FOV: 45 degrees: 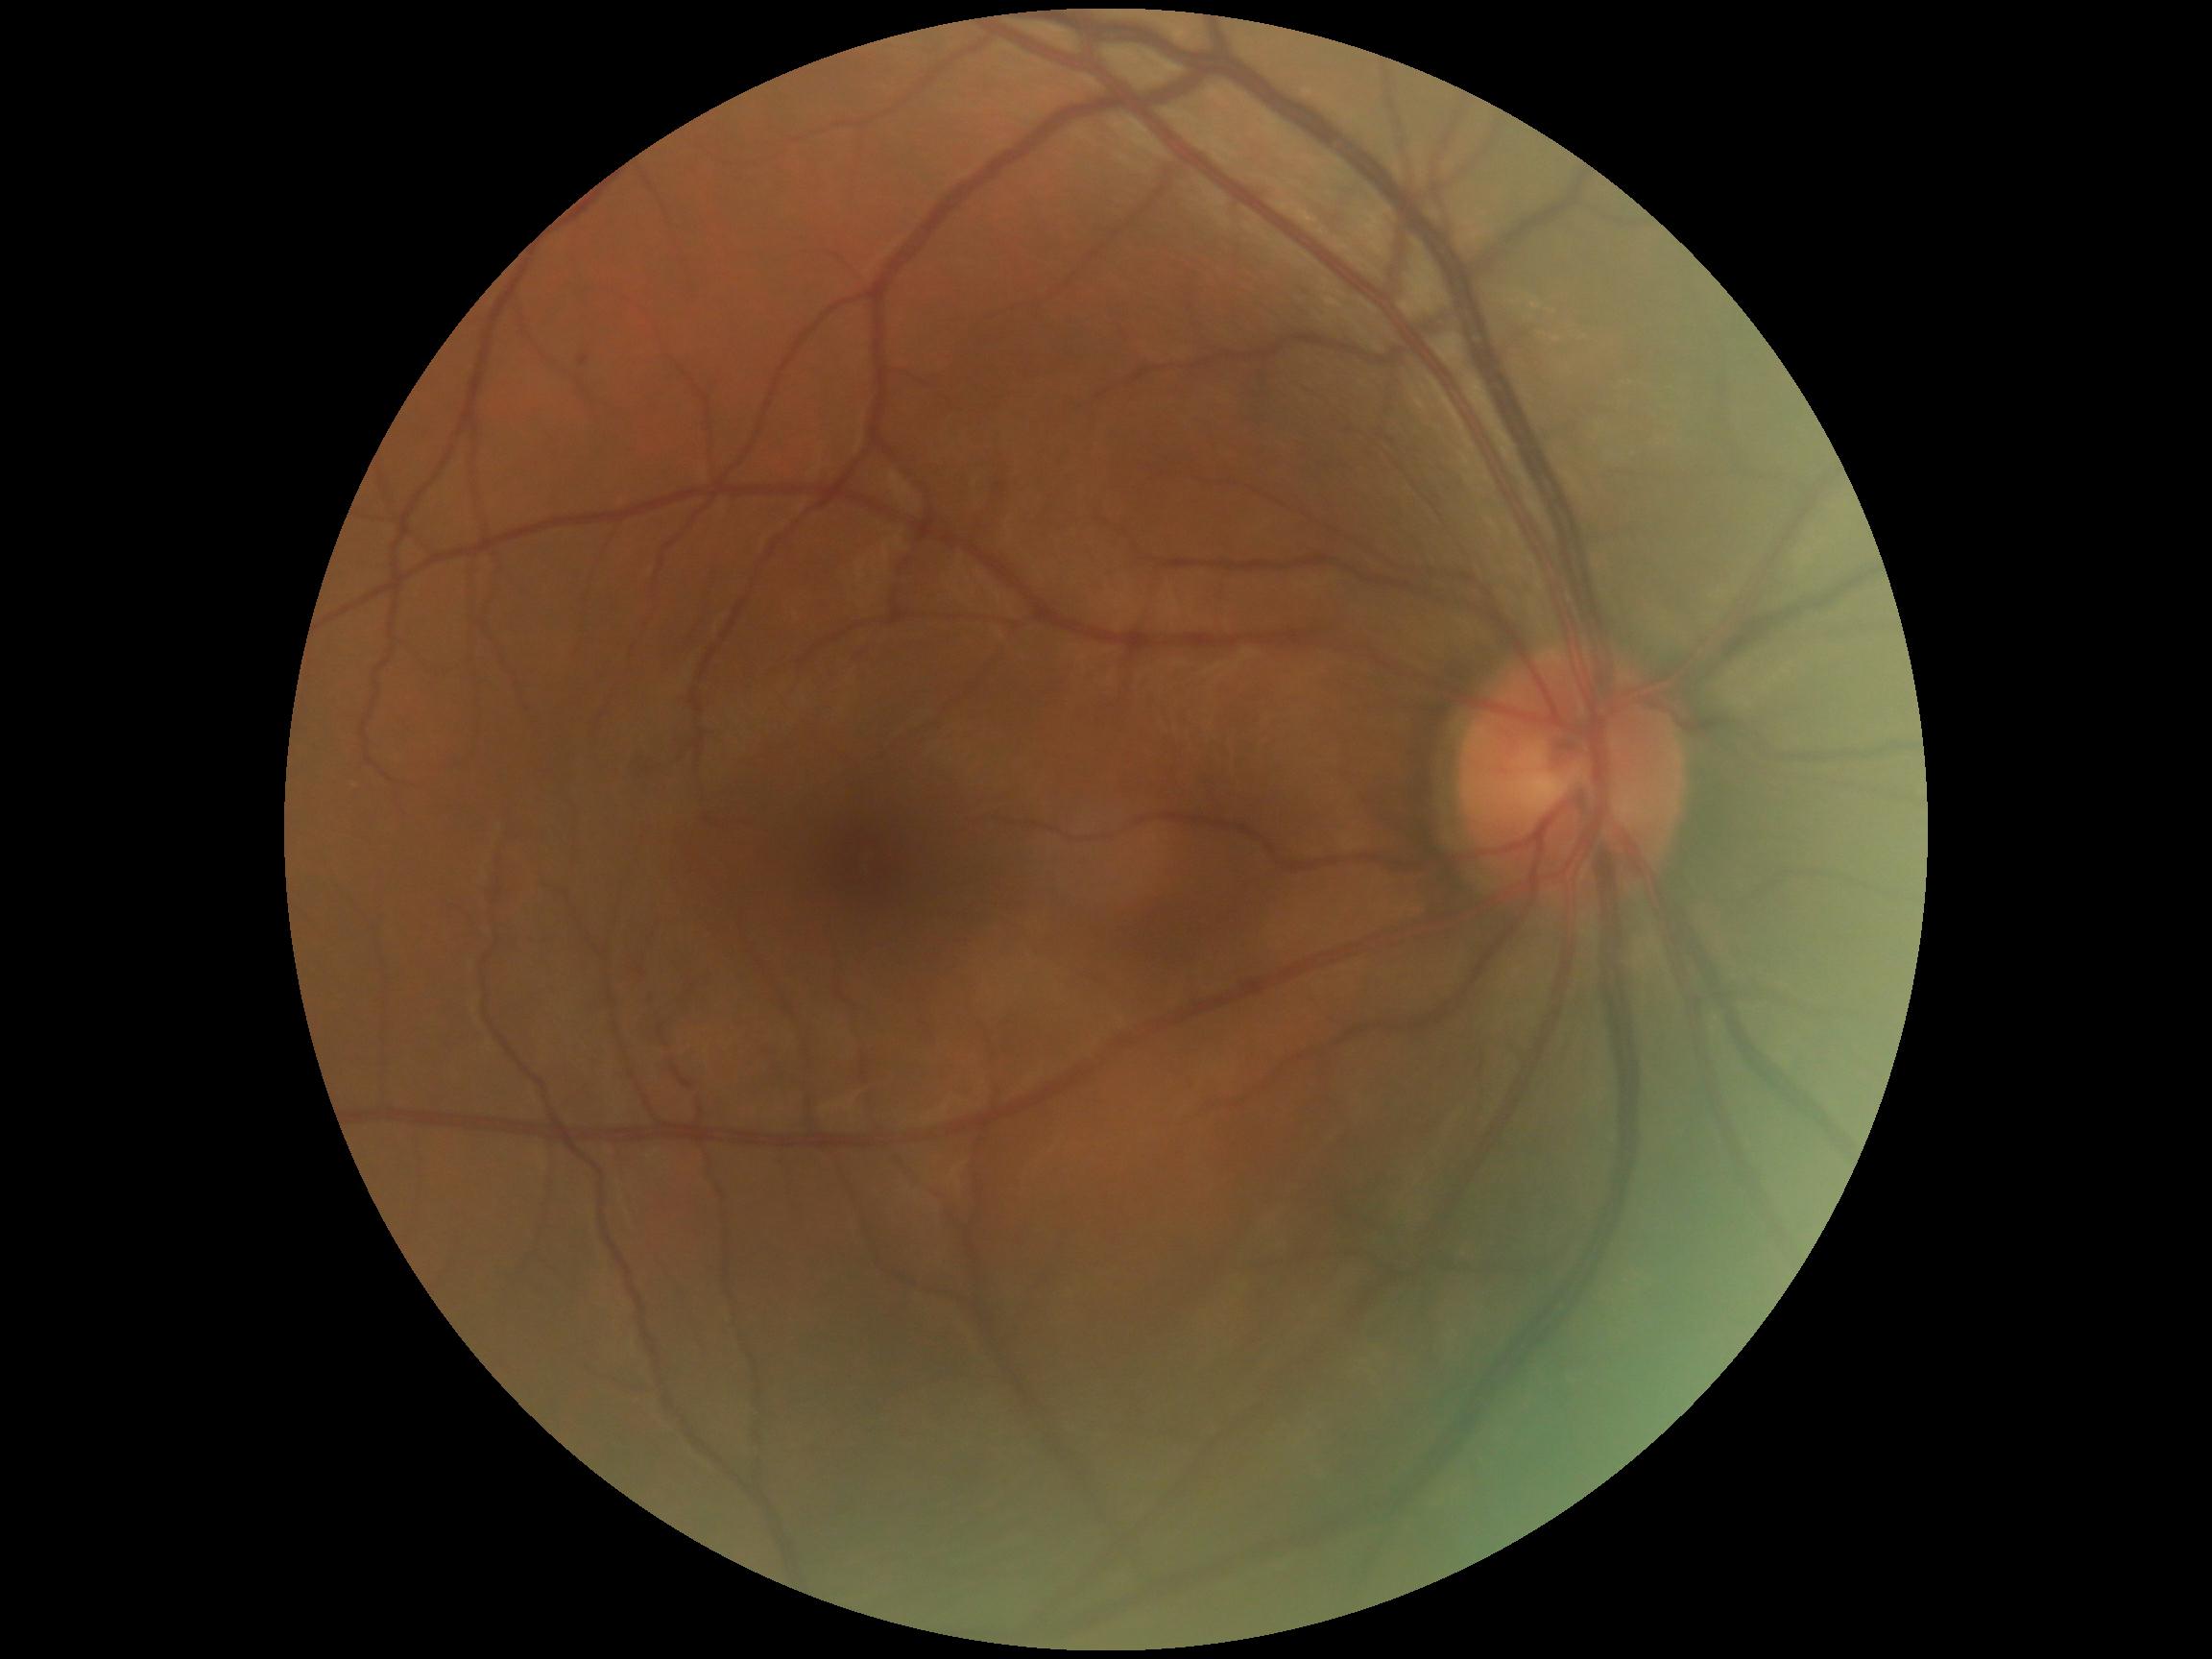
Annotations:
* diabetic retinopathy severity: 1/4 — presence of microaneurysms only